CFP · 2089x1764px.
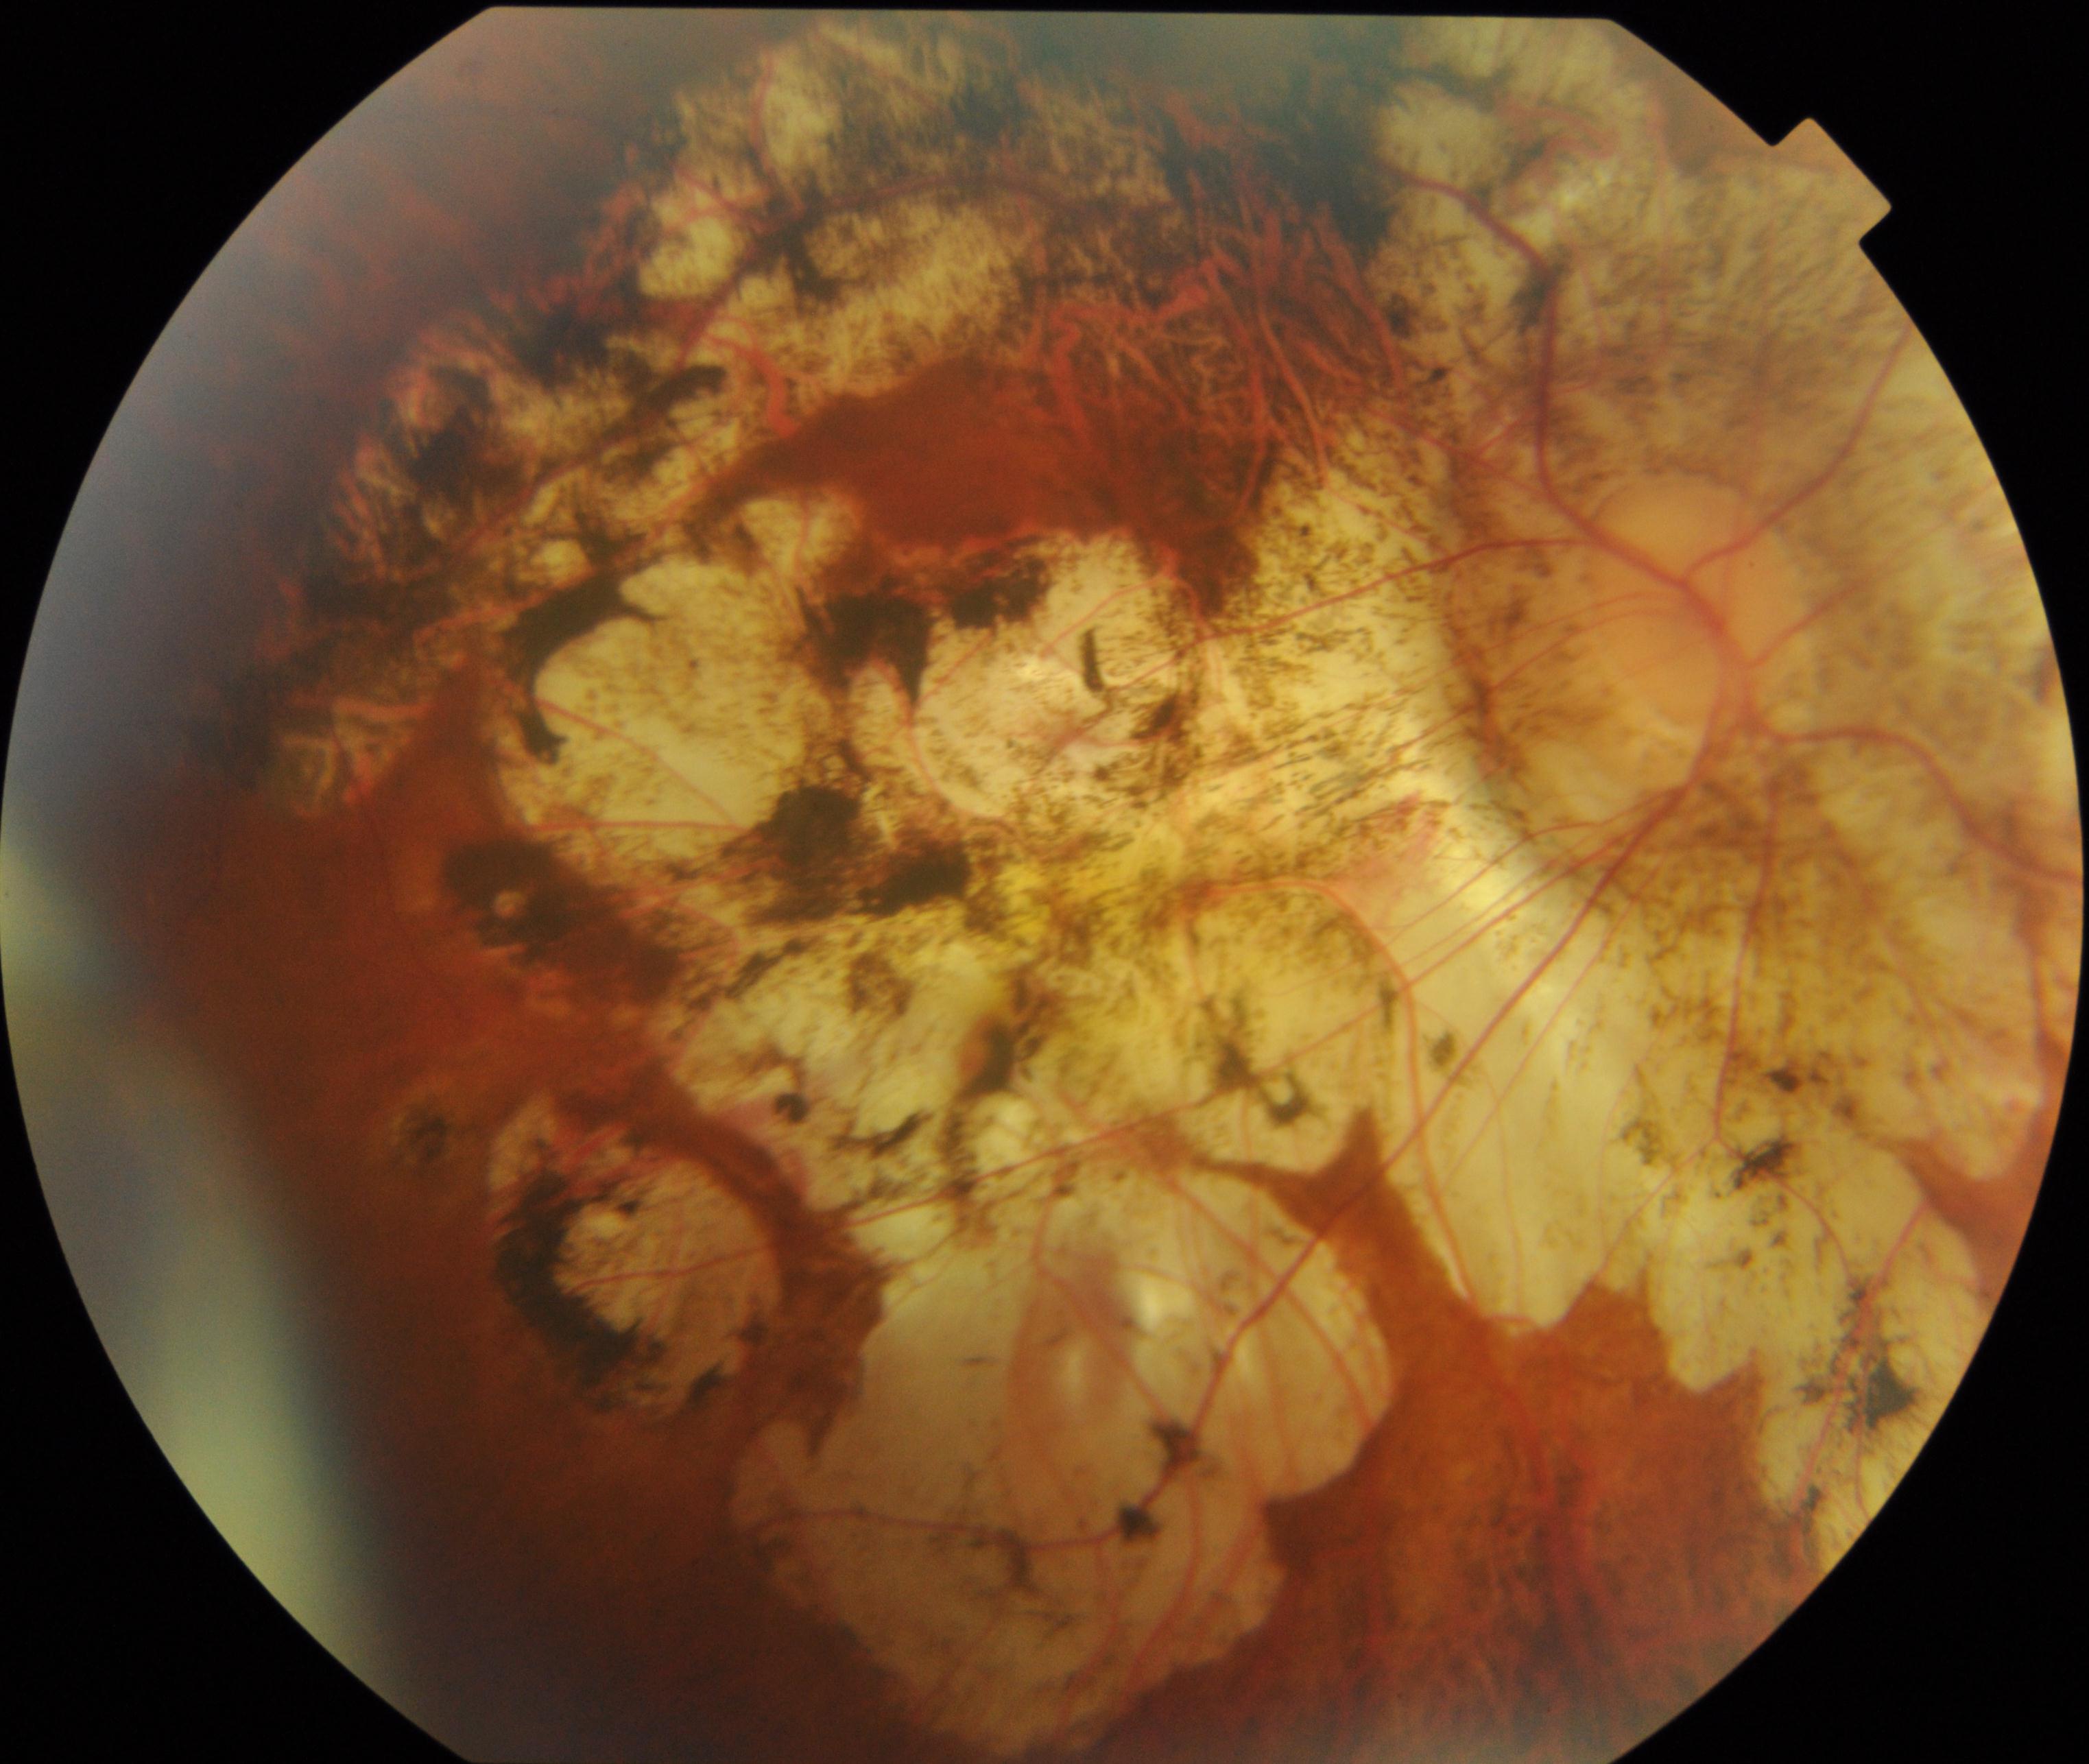
The image shows pathological myopia.